FOV: 45 degrees · nonmydriatic · NIDEK AFC-230: 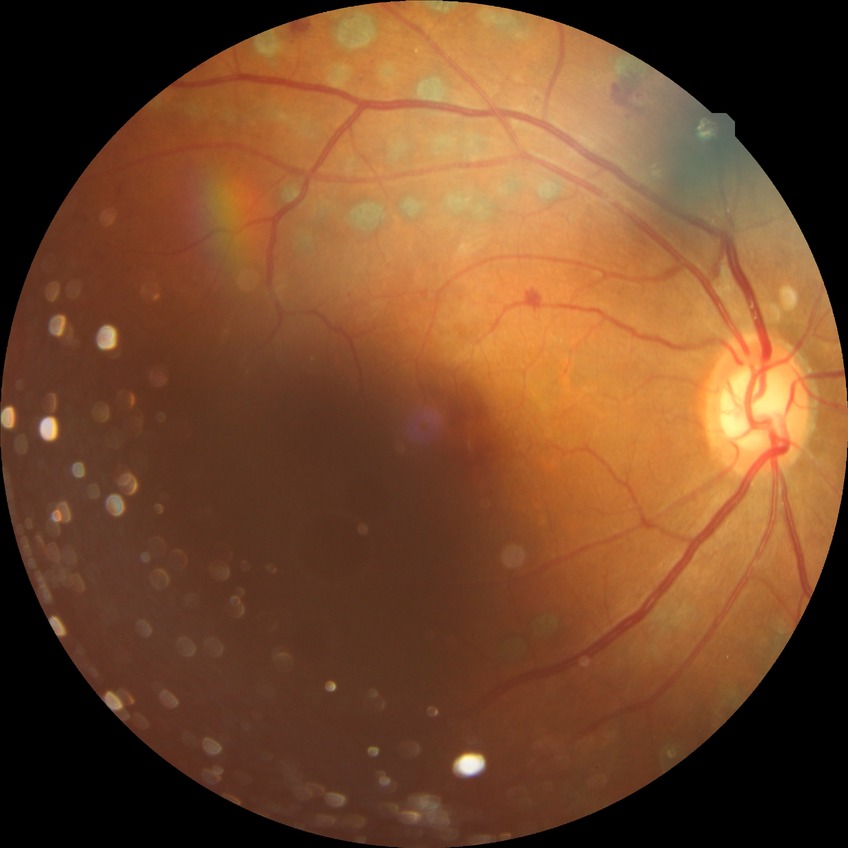 DR class: non-proliferative diabetic retinopathy. Davis stage is SDR.